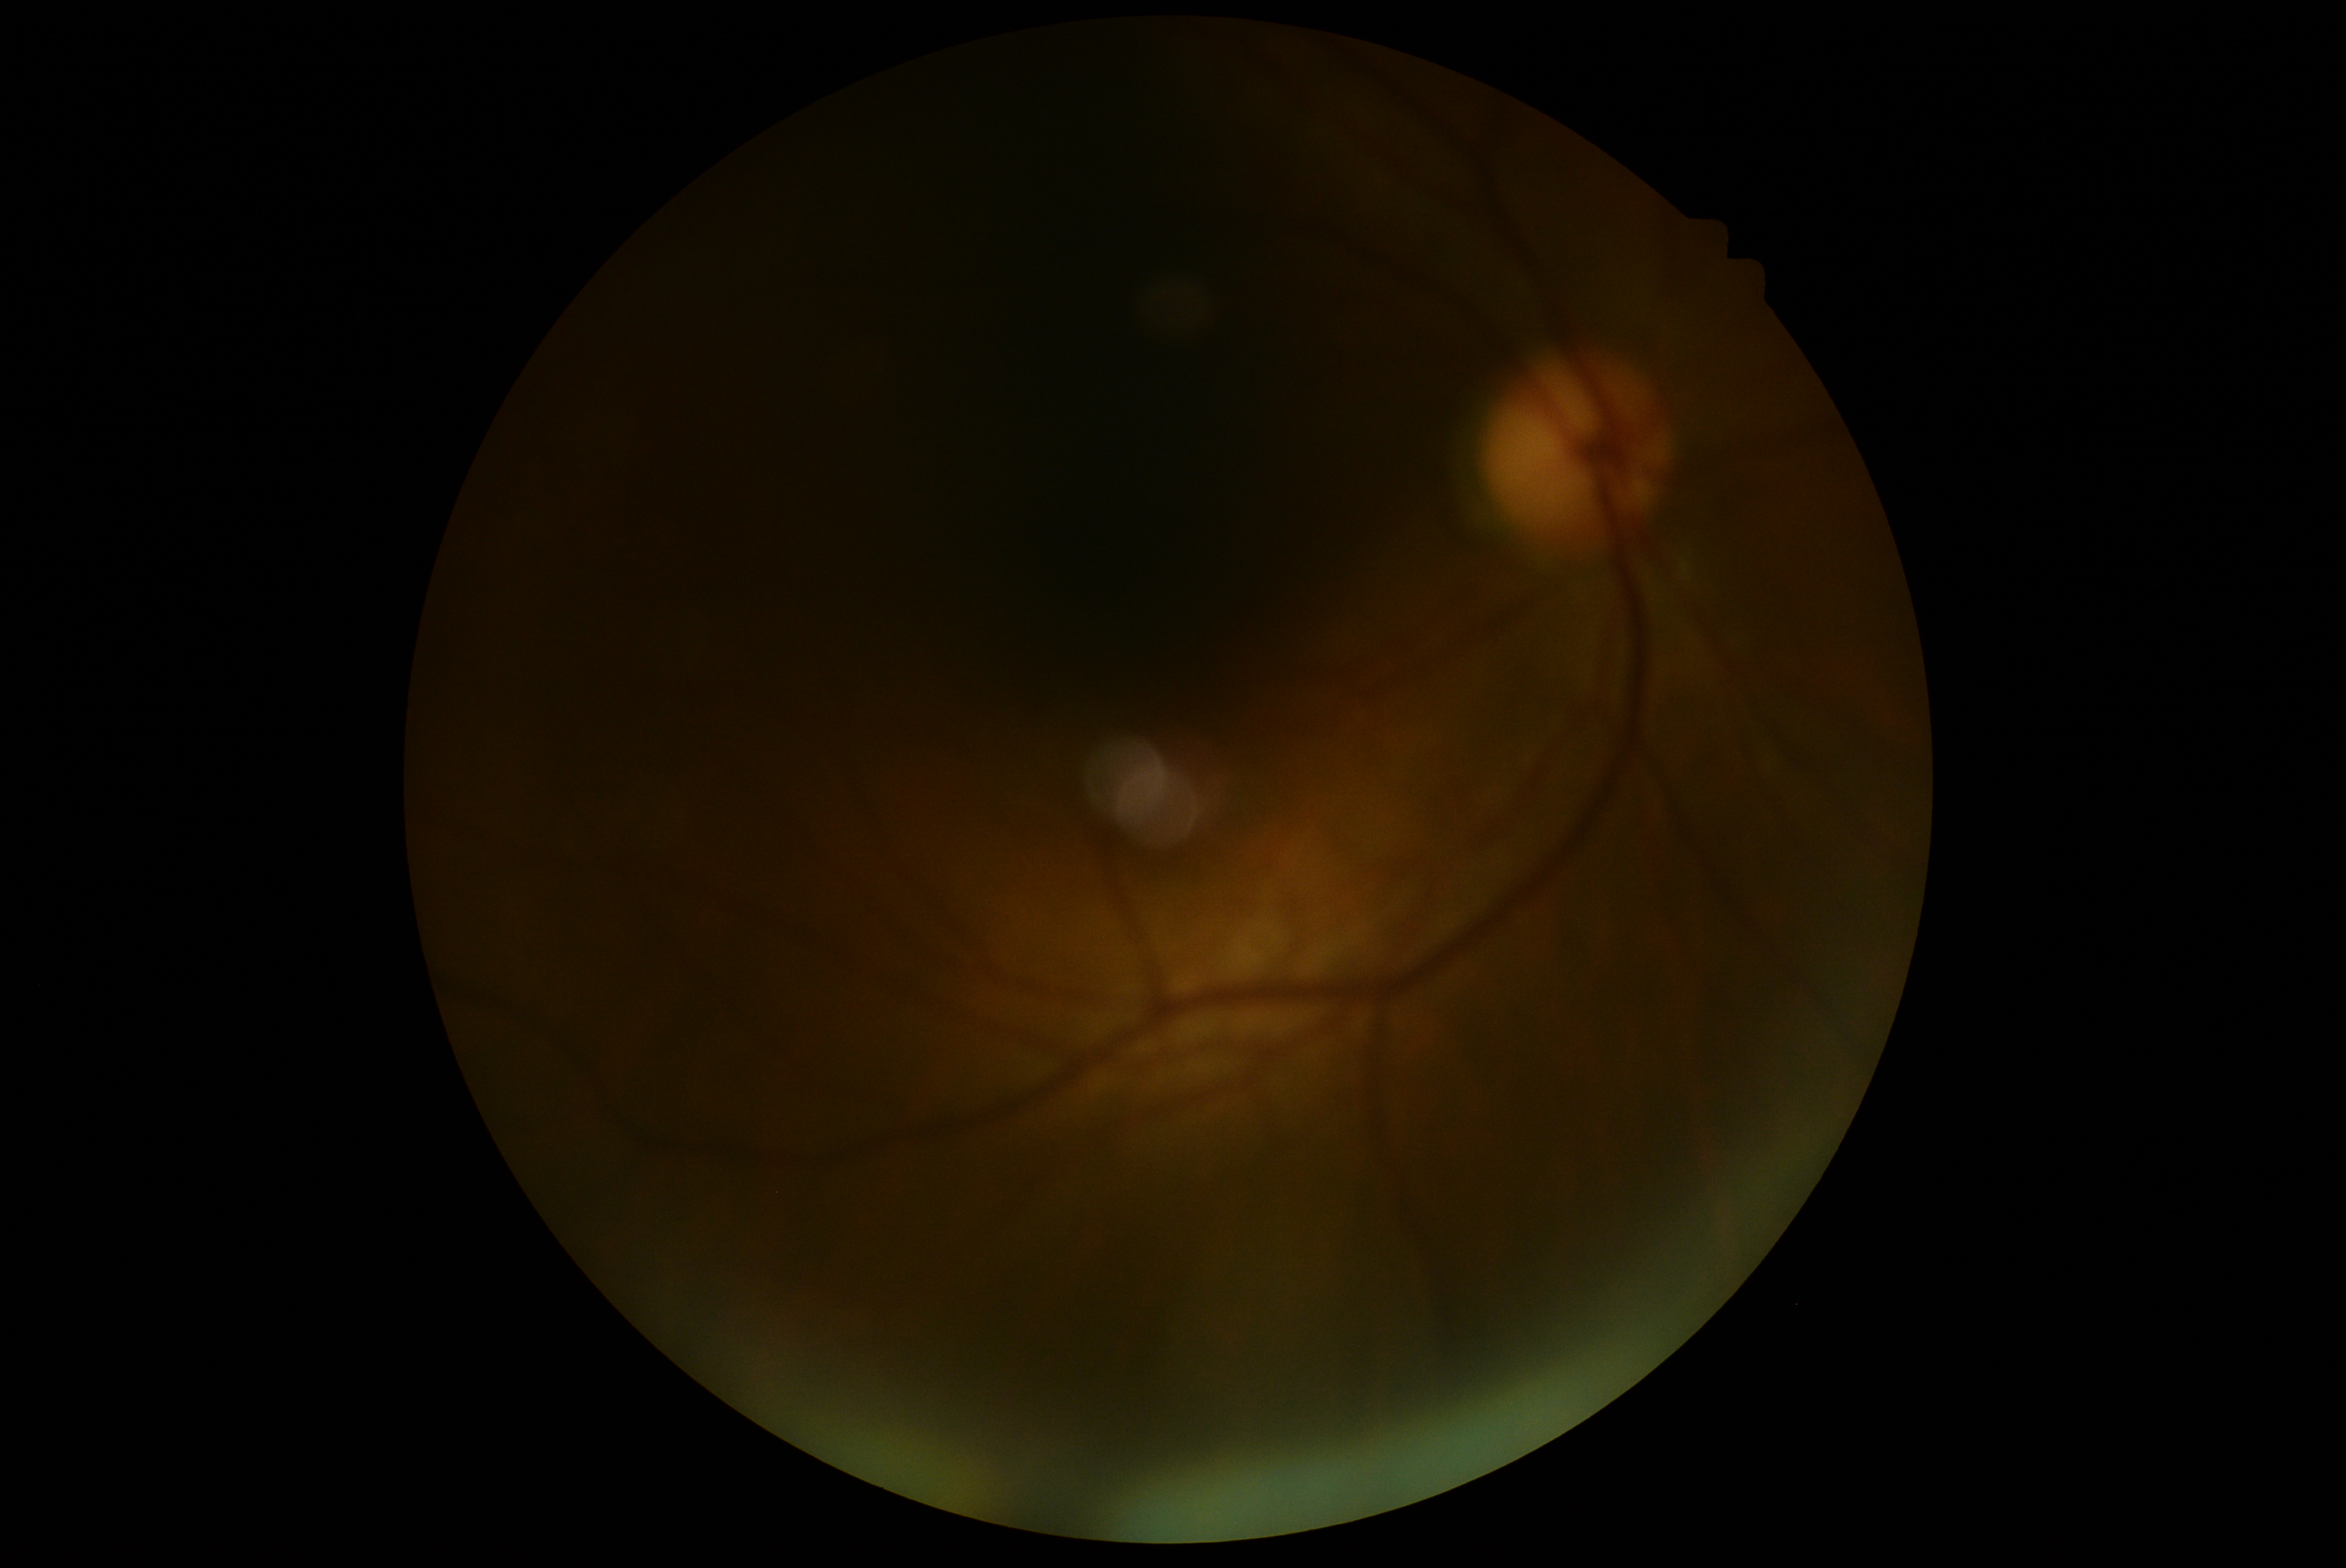
Diabetic retinopathy (DR) is ungradable. Image quality is insufficient for diabetic retinopathy assessment.